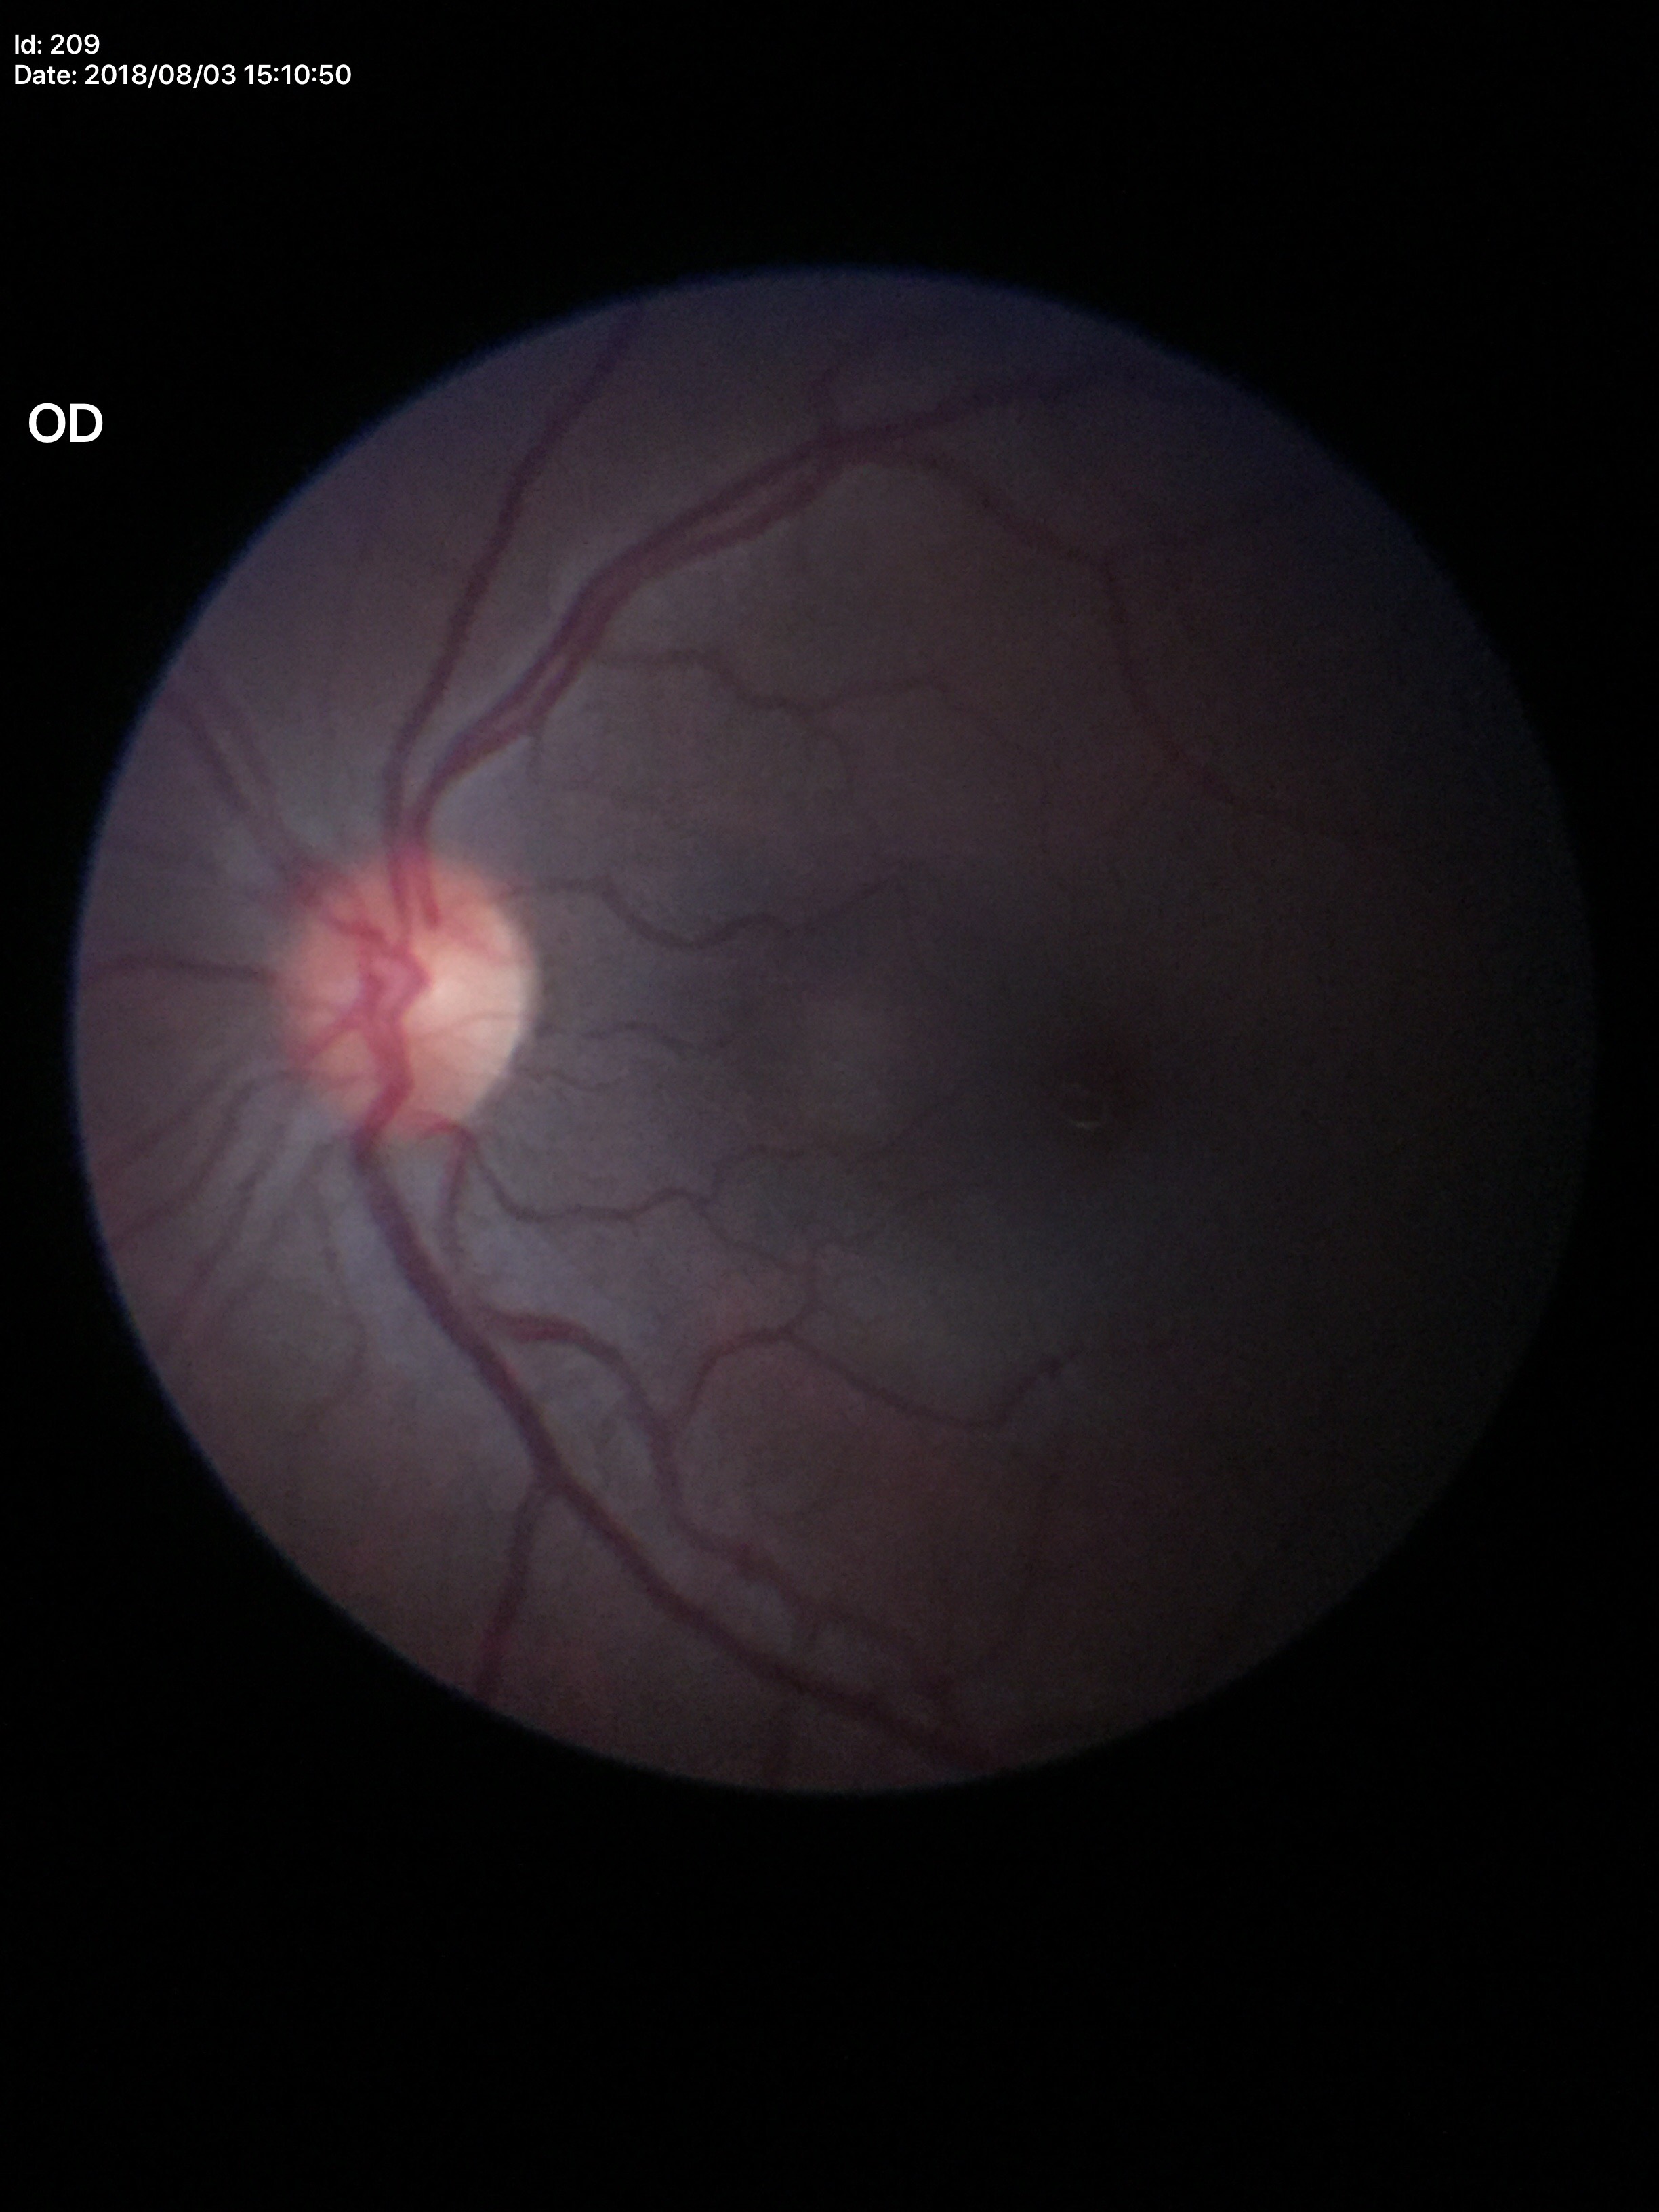
• Glaucoma evaluation — no suspicious findings
• vertical cup-to-disc ratio — 0.49